2352x1568px; 45-degree field of view:
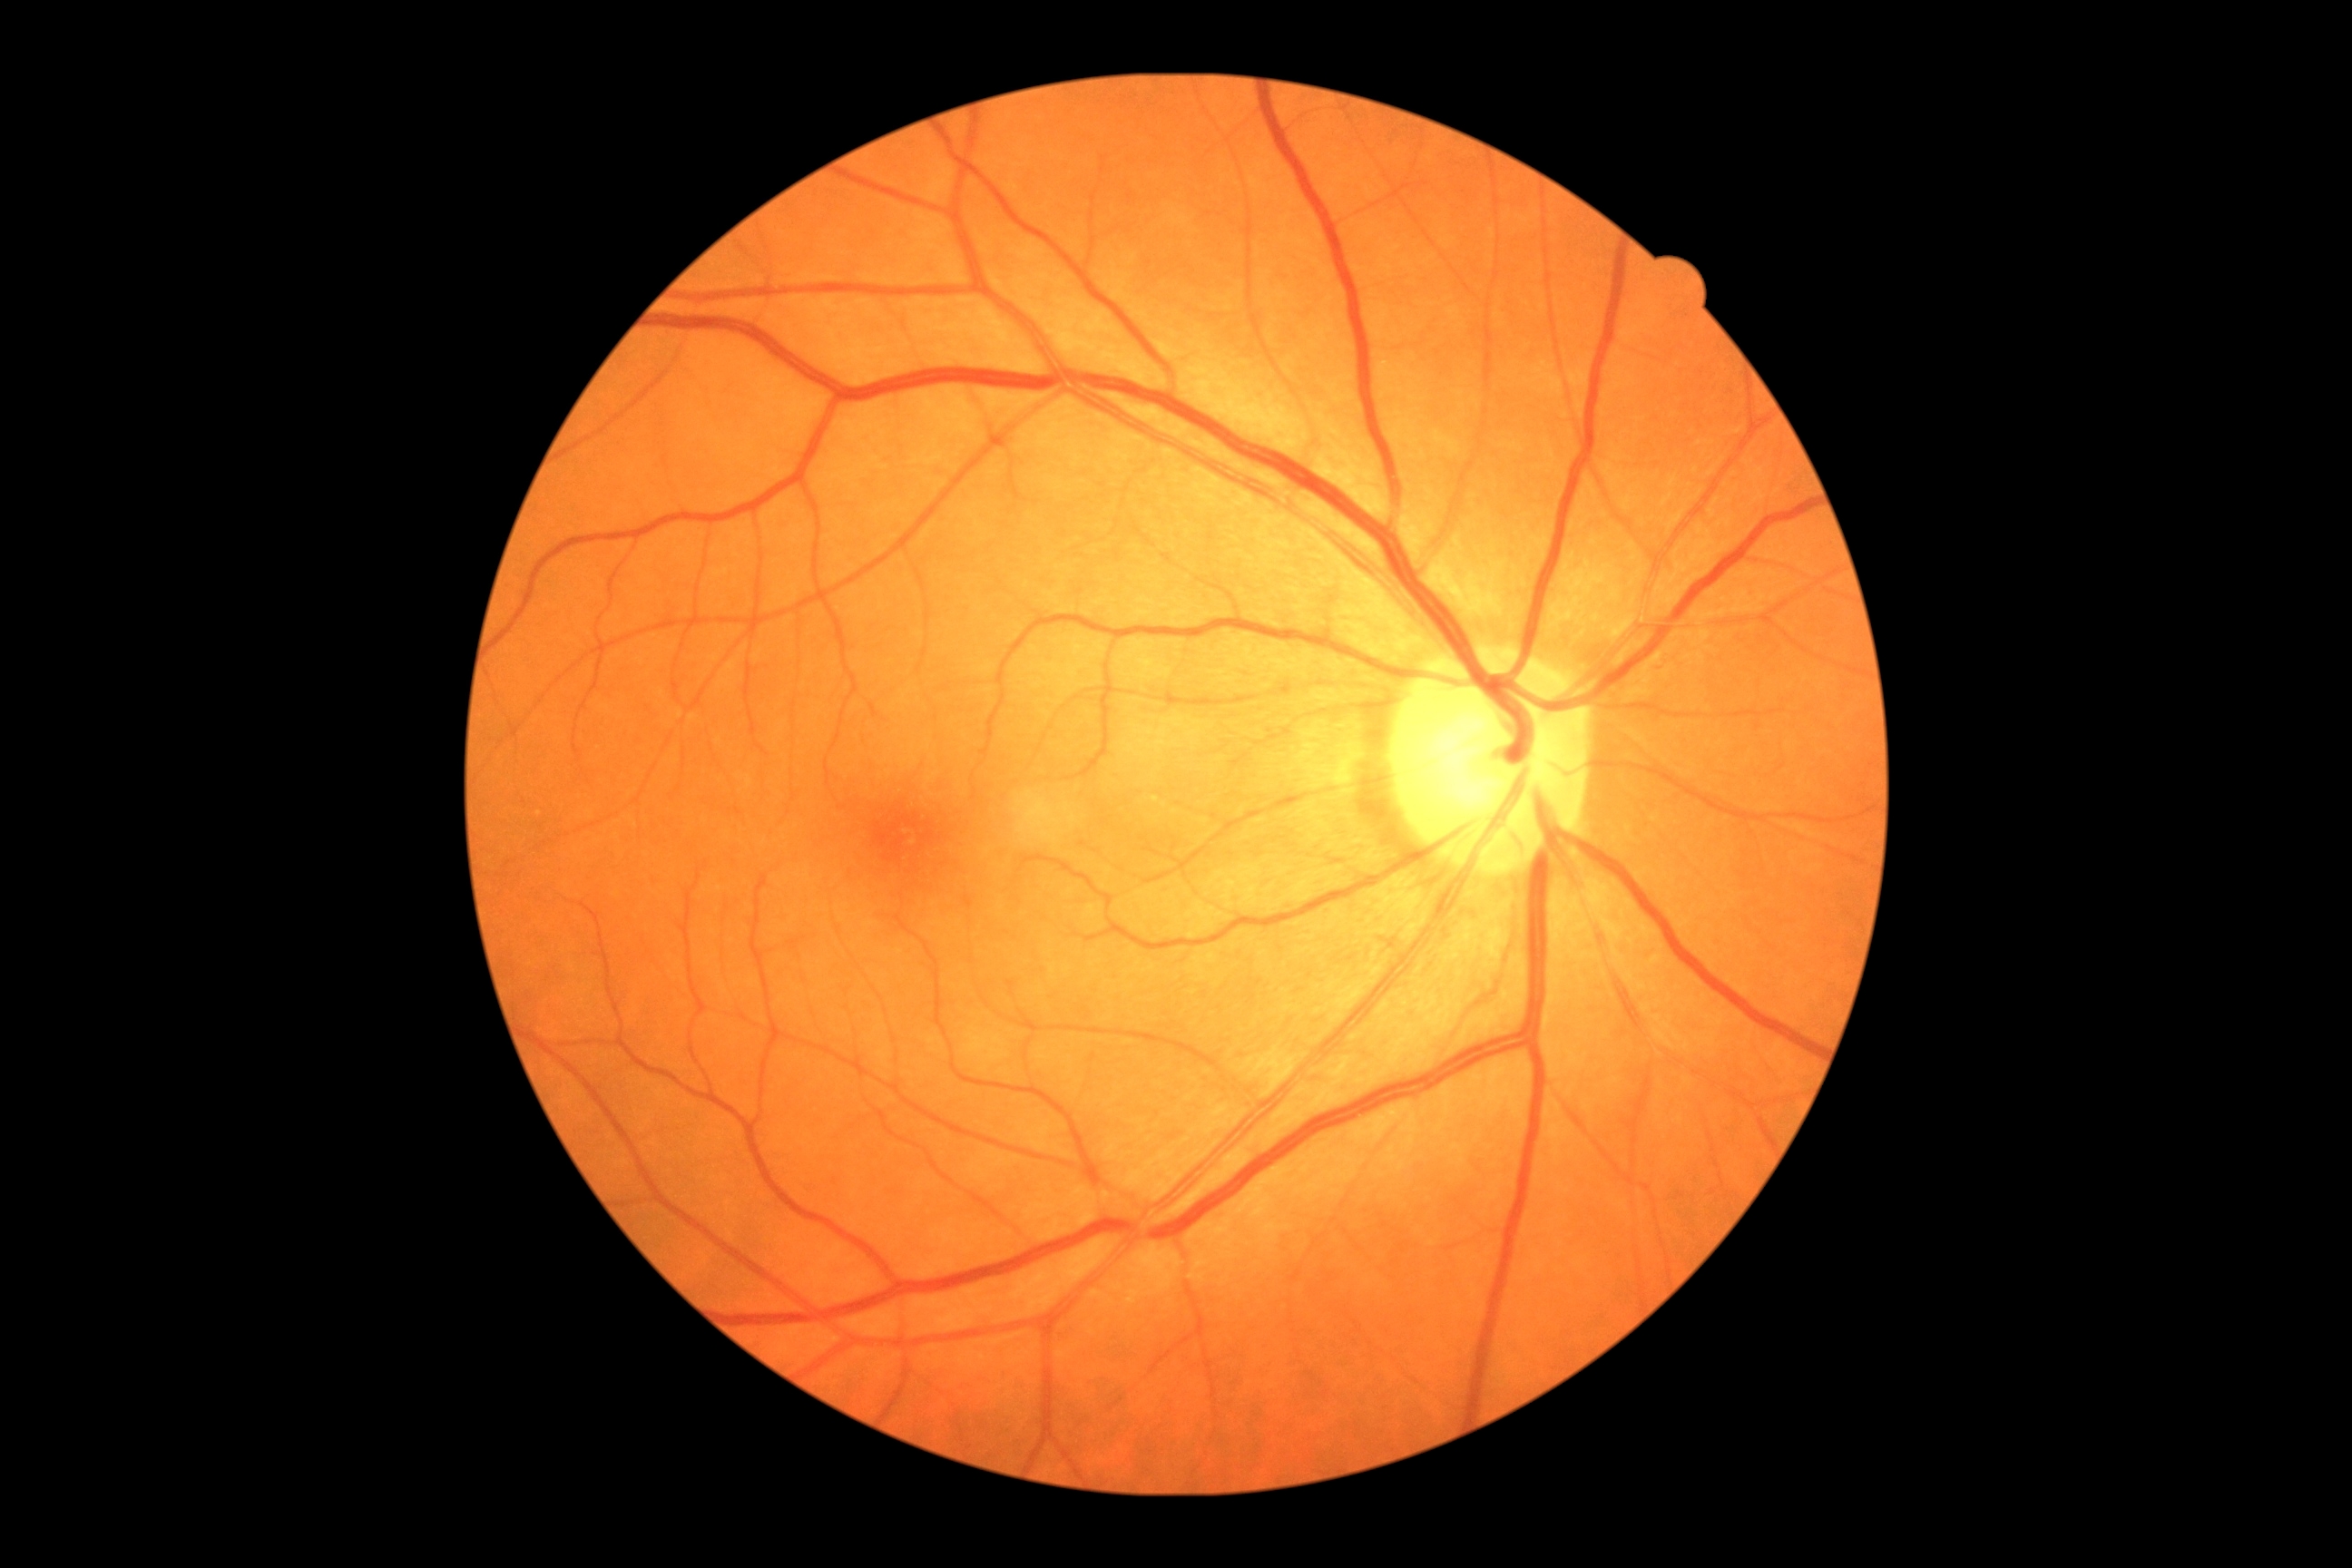
No diabetic retinal disease findings.
Diabetic retinopathy (DR) is no apparent diabetic retinopathy (grade 0).